FOV: 45 degrees; 2352 x 1568 pixels.
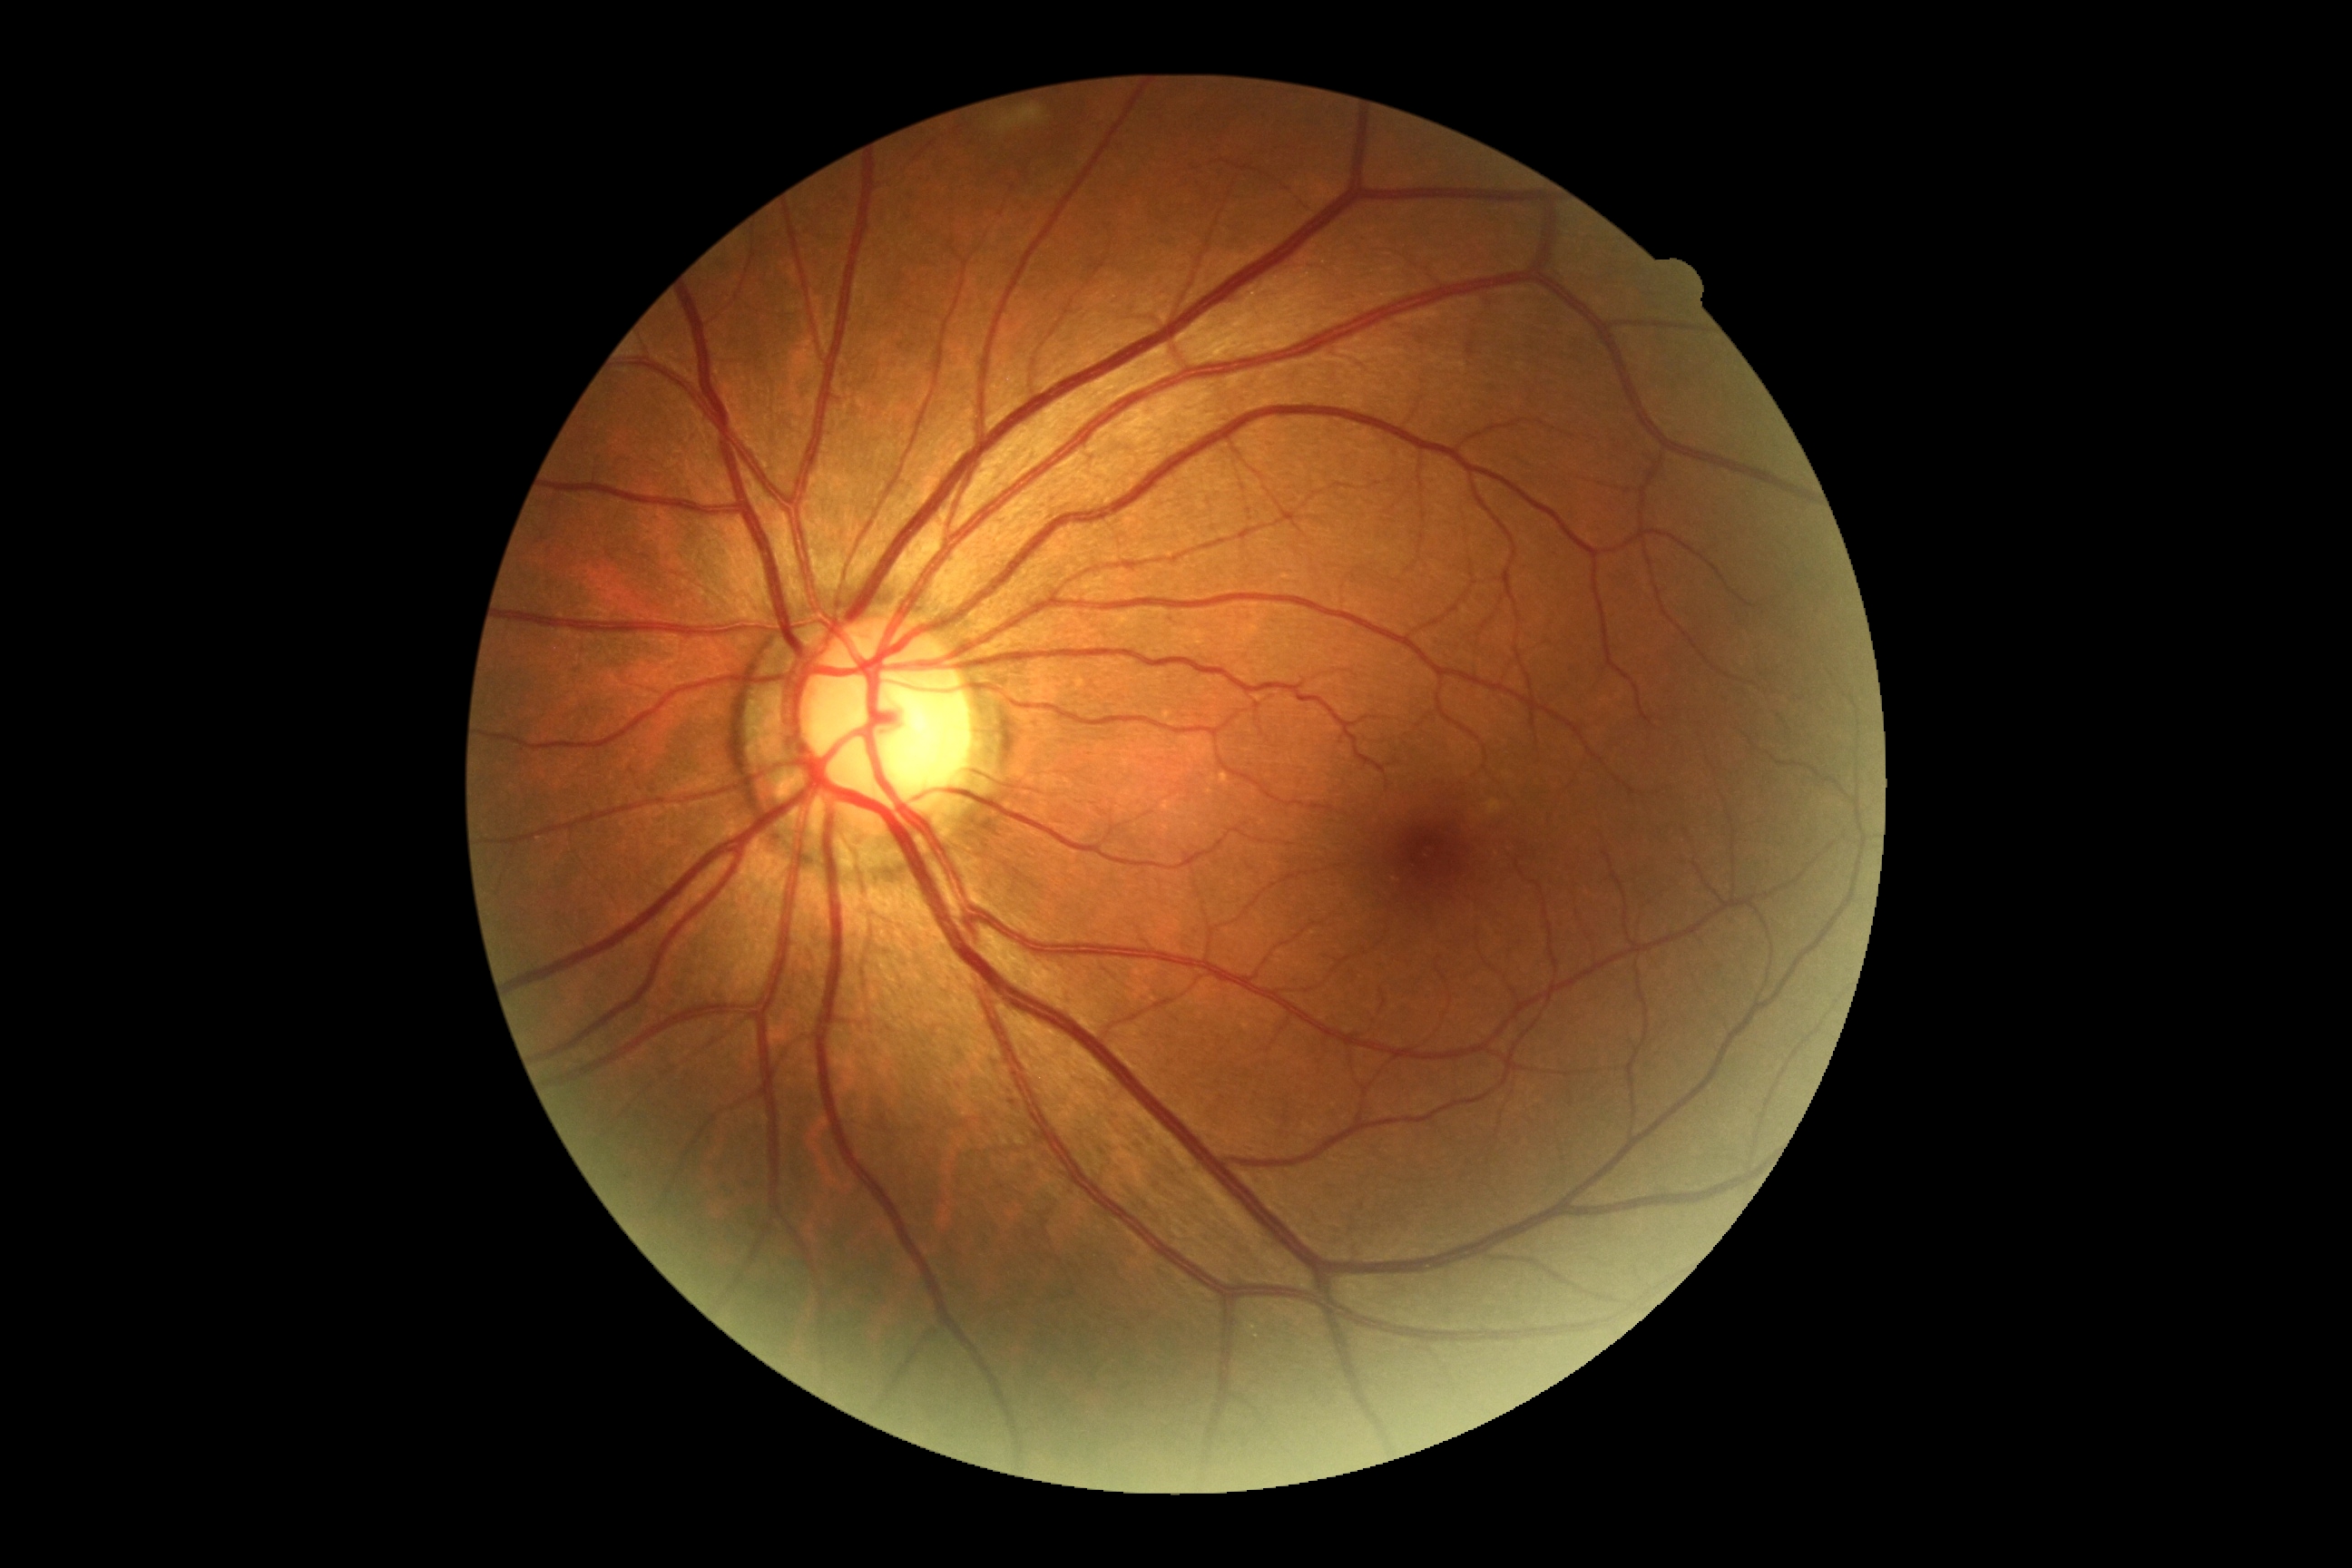

diabetic retinopathy (DR) = no apparent retinopathy (grade 0)